2352x1568px
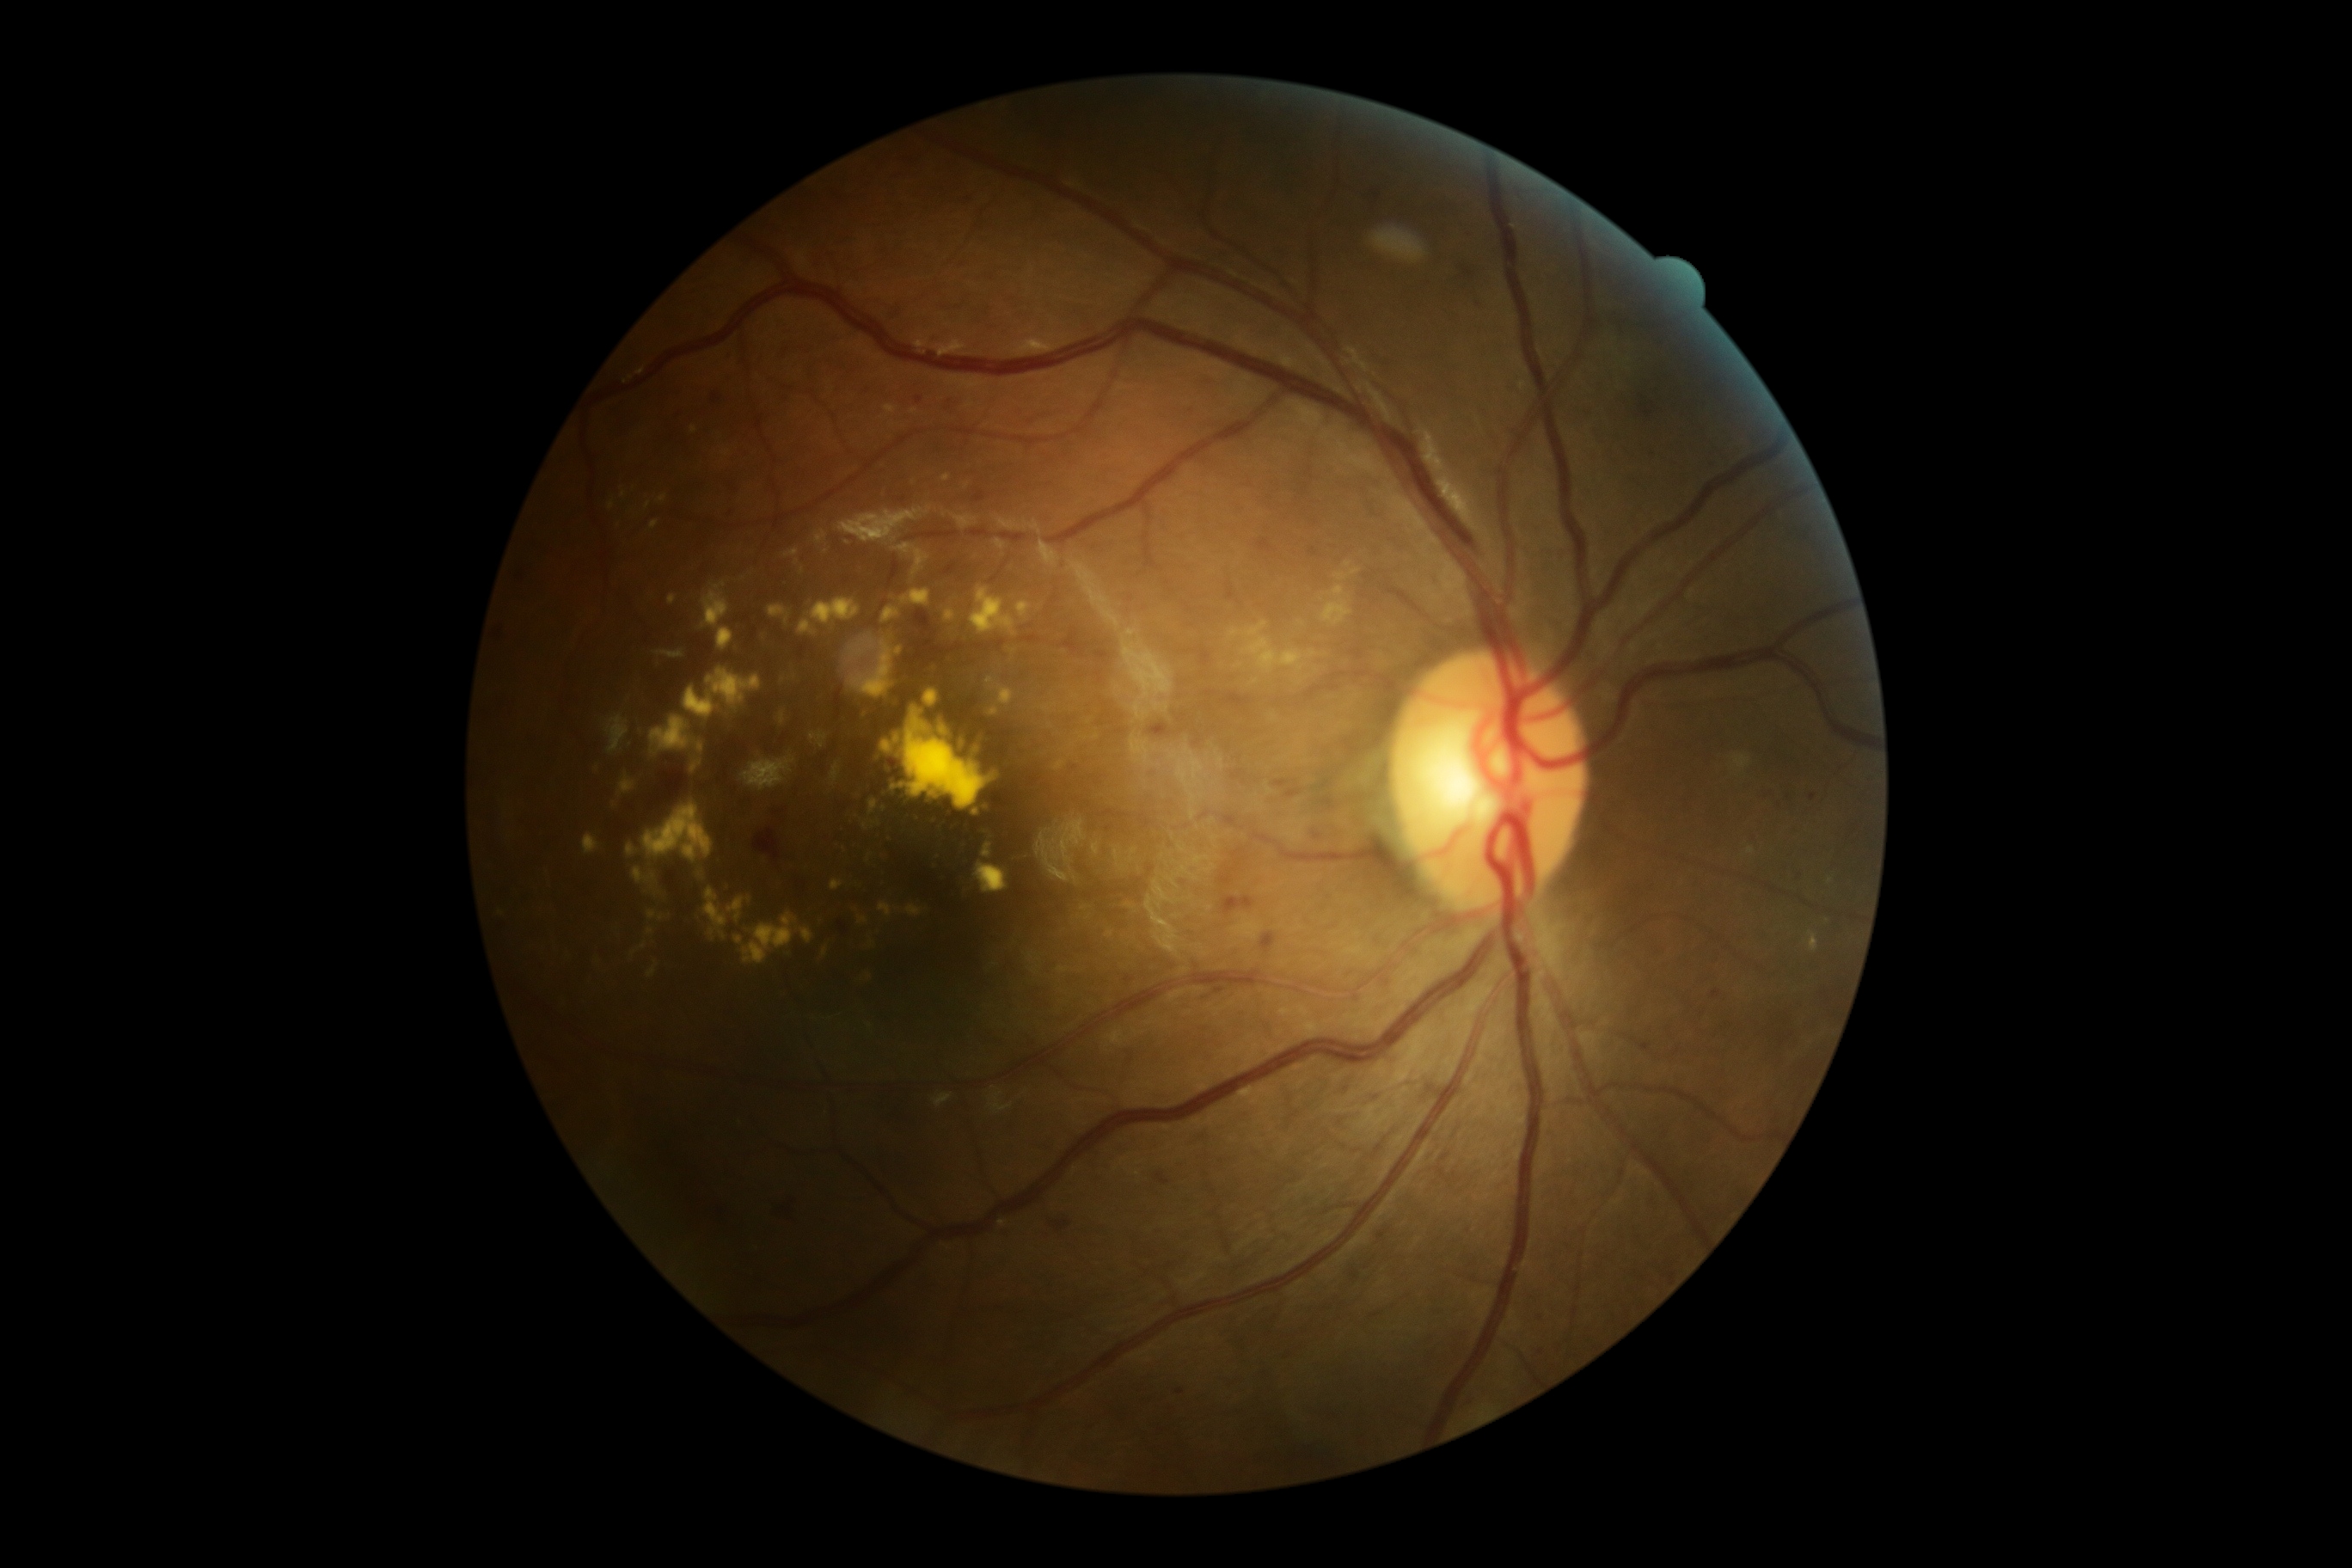

partial: true
dr_grade: 2
dr_grade_name: moderate NPDR
lesions:
  ex:
    - <box>862,823,869,831</box>
    - <box>651,885,663,897</box>
    - <box>867,854,873,864</box>
    - <box>627,843,637,857</box>
    - <box>811,732,828,749</box>
    - <box>702,582,730,628</box>
    - <box>859,916,869,926</box>
    - <box>658,494,666,503</box>
    - <box>618,775,637,797</box>
    - <box>630,943,646,957</box>
    - <box>1808,931,1820,953</box>
    - <box>797,620,818,637</box>
    - <box>983,847,991,859</box>
    - <box>745,754,797,792</box>
    - <box>644,804,713,862</box>
  ex_small:
    - (694,430)
    - (869,977)
    - (946,478)
    - (624,495)
    - (783,680)